Wide-field fundus photograph of an infant; 1240 x 1240 pixels:
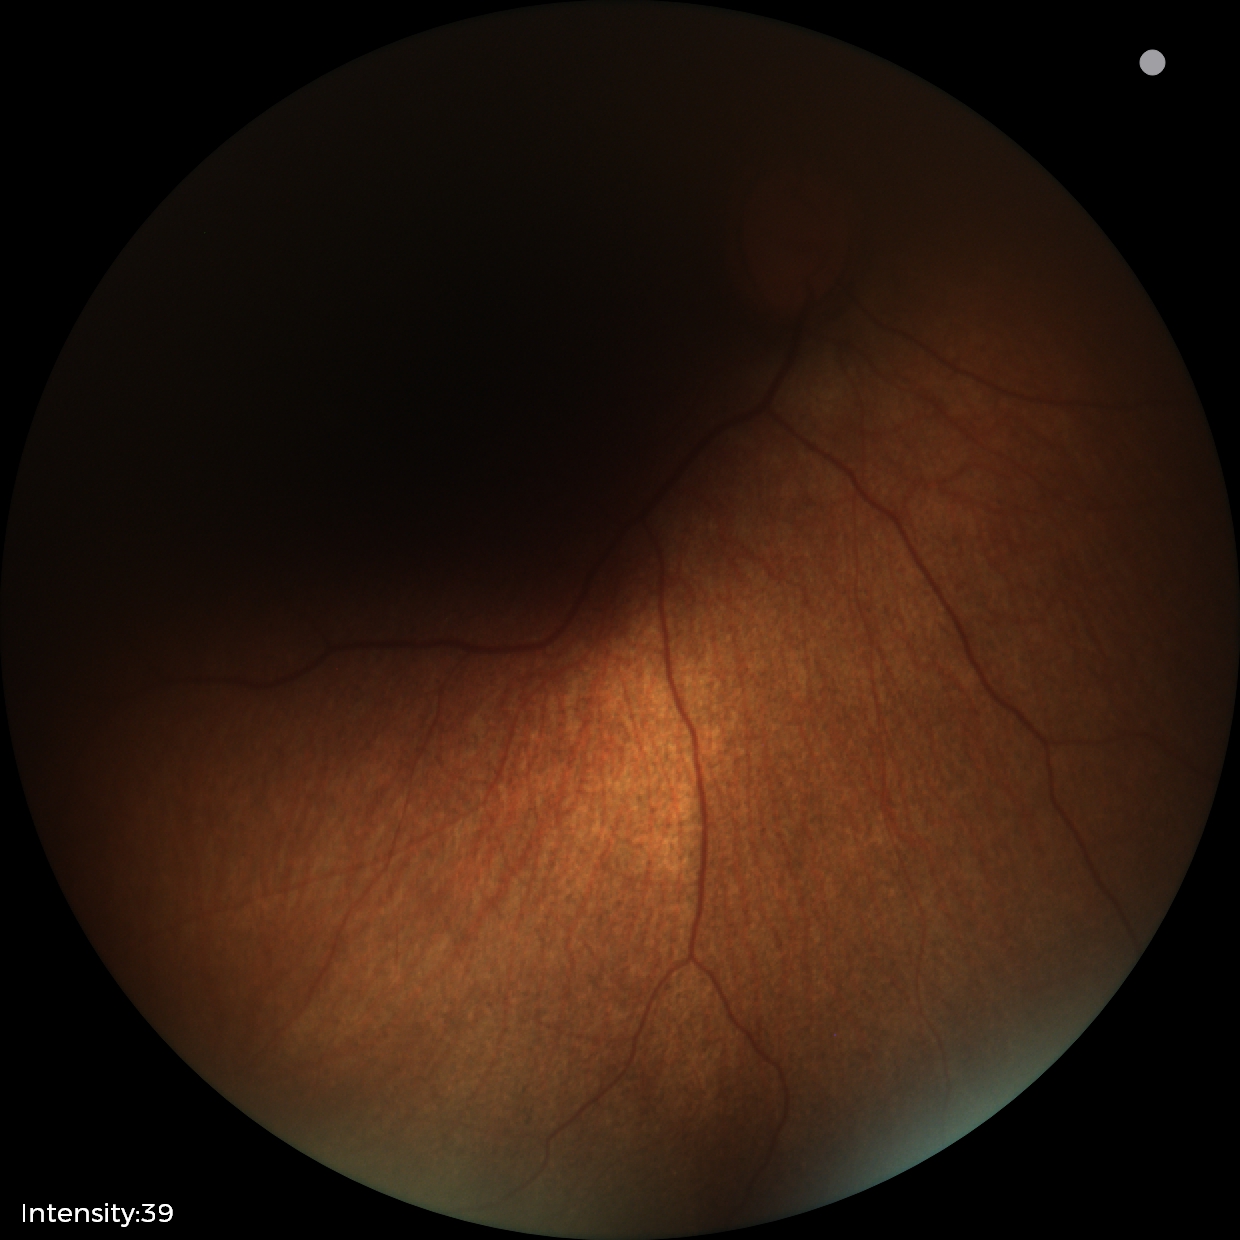
Physiological retinal appearance for postconceptual age.